Wide-field fundus photograph of an infant · 1240x1240px
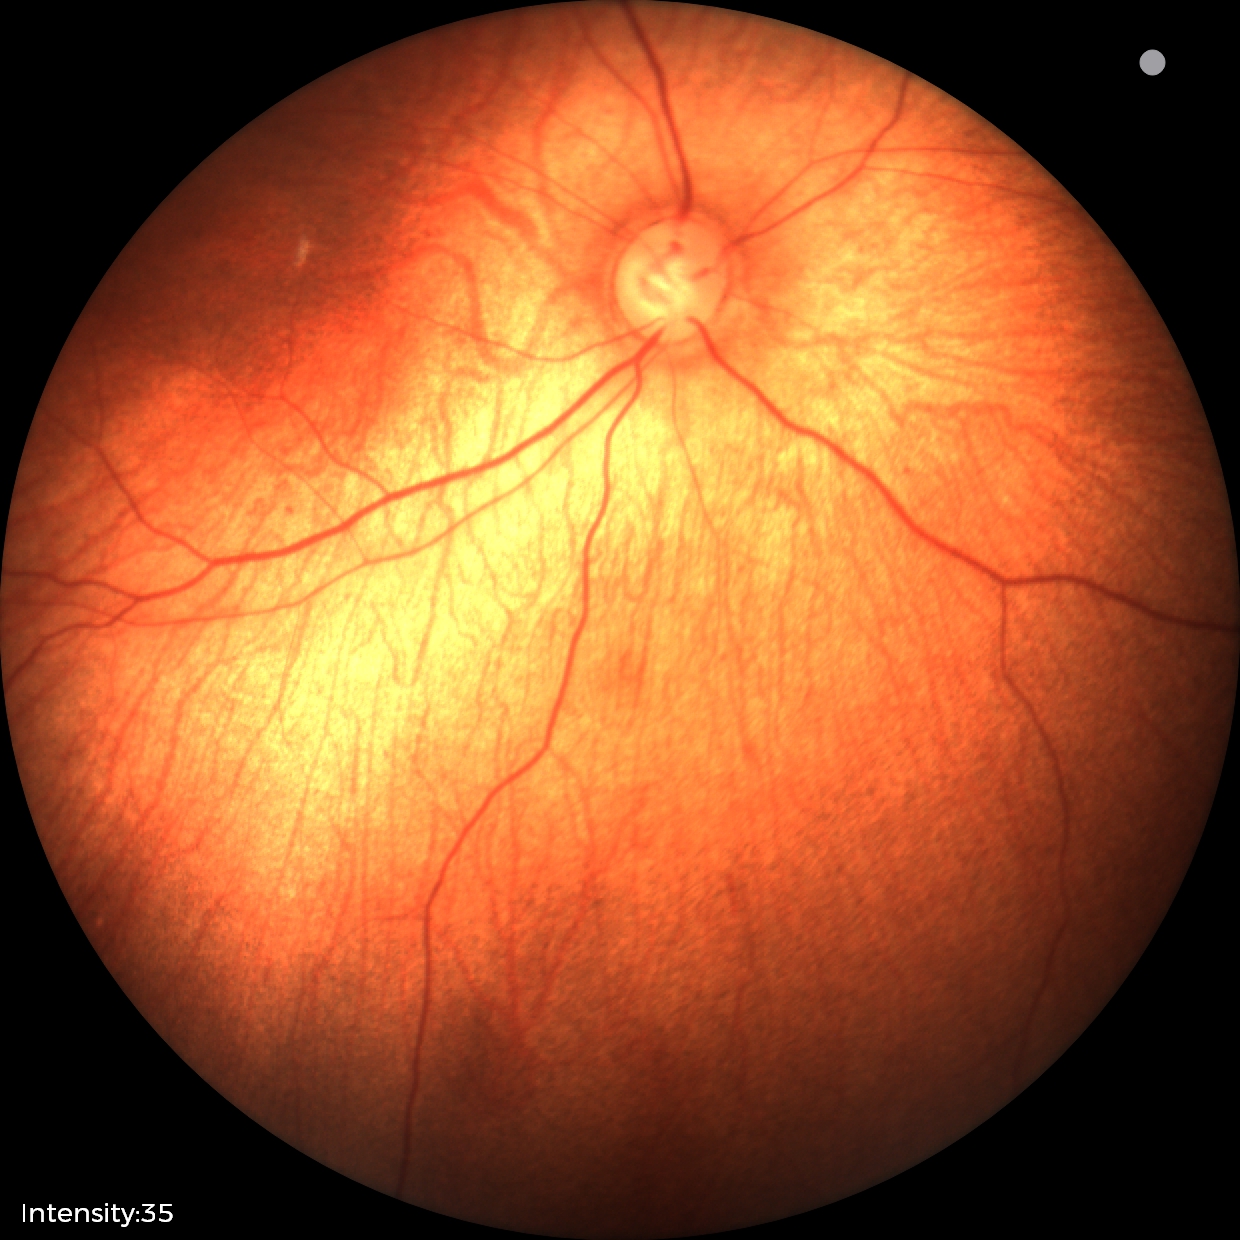
Finding = physiological.